CFP. Image size 2212x1659:
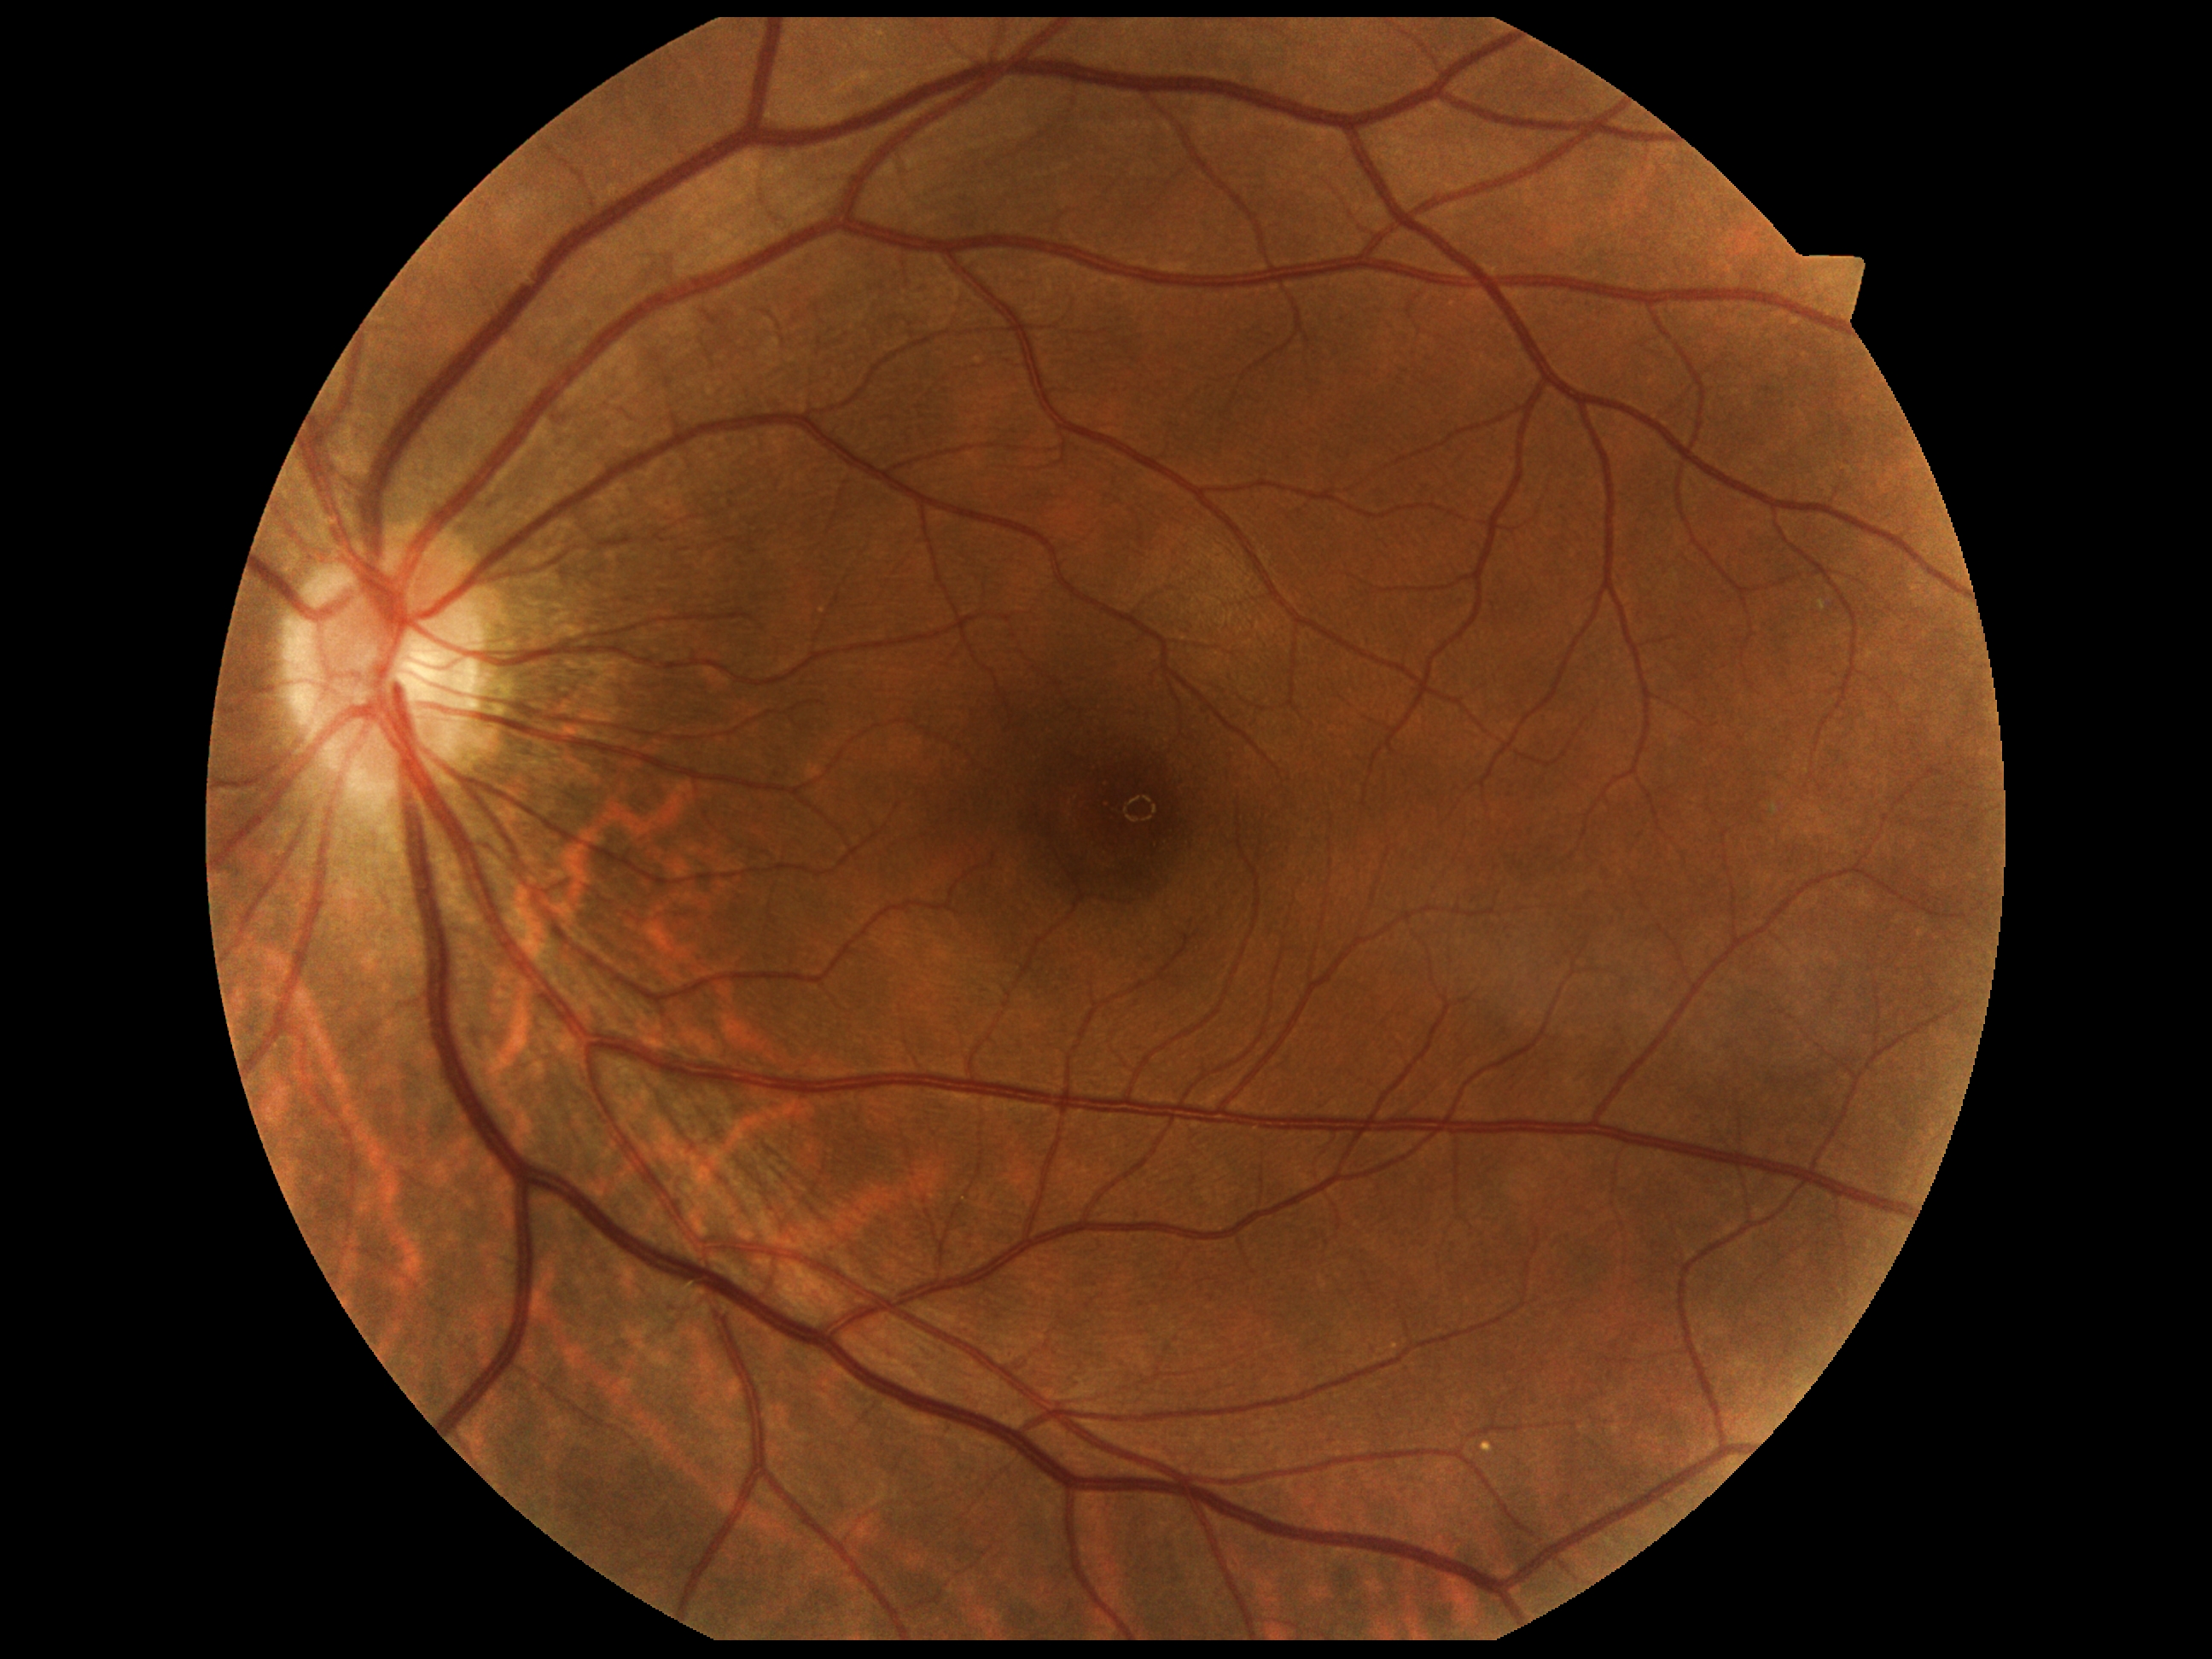
Diabetic retinopathy: grade 0.